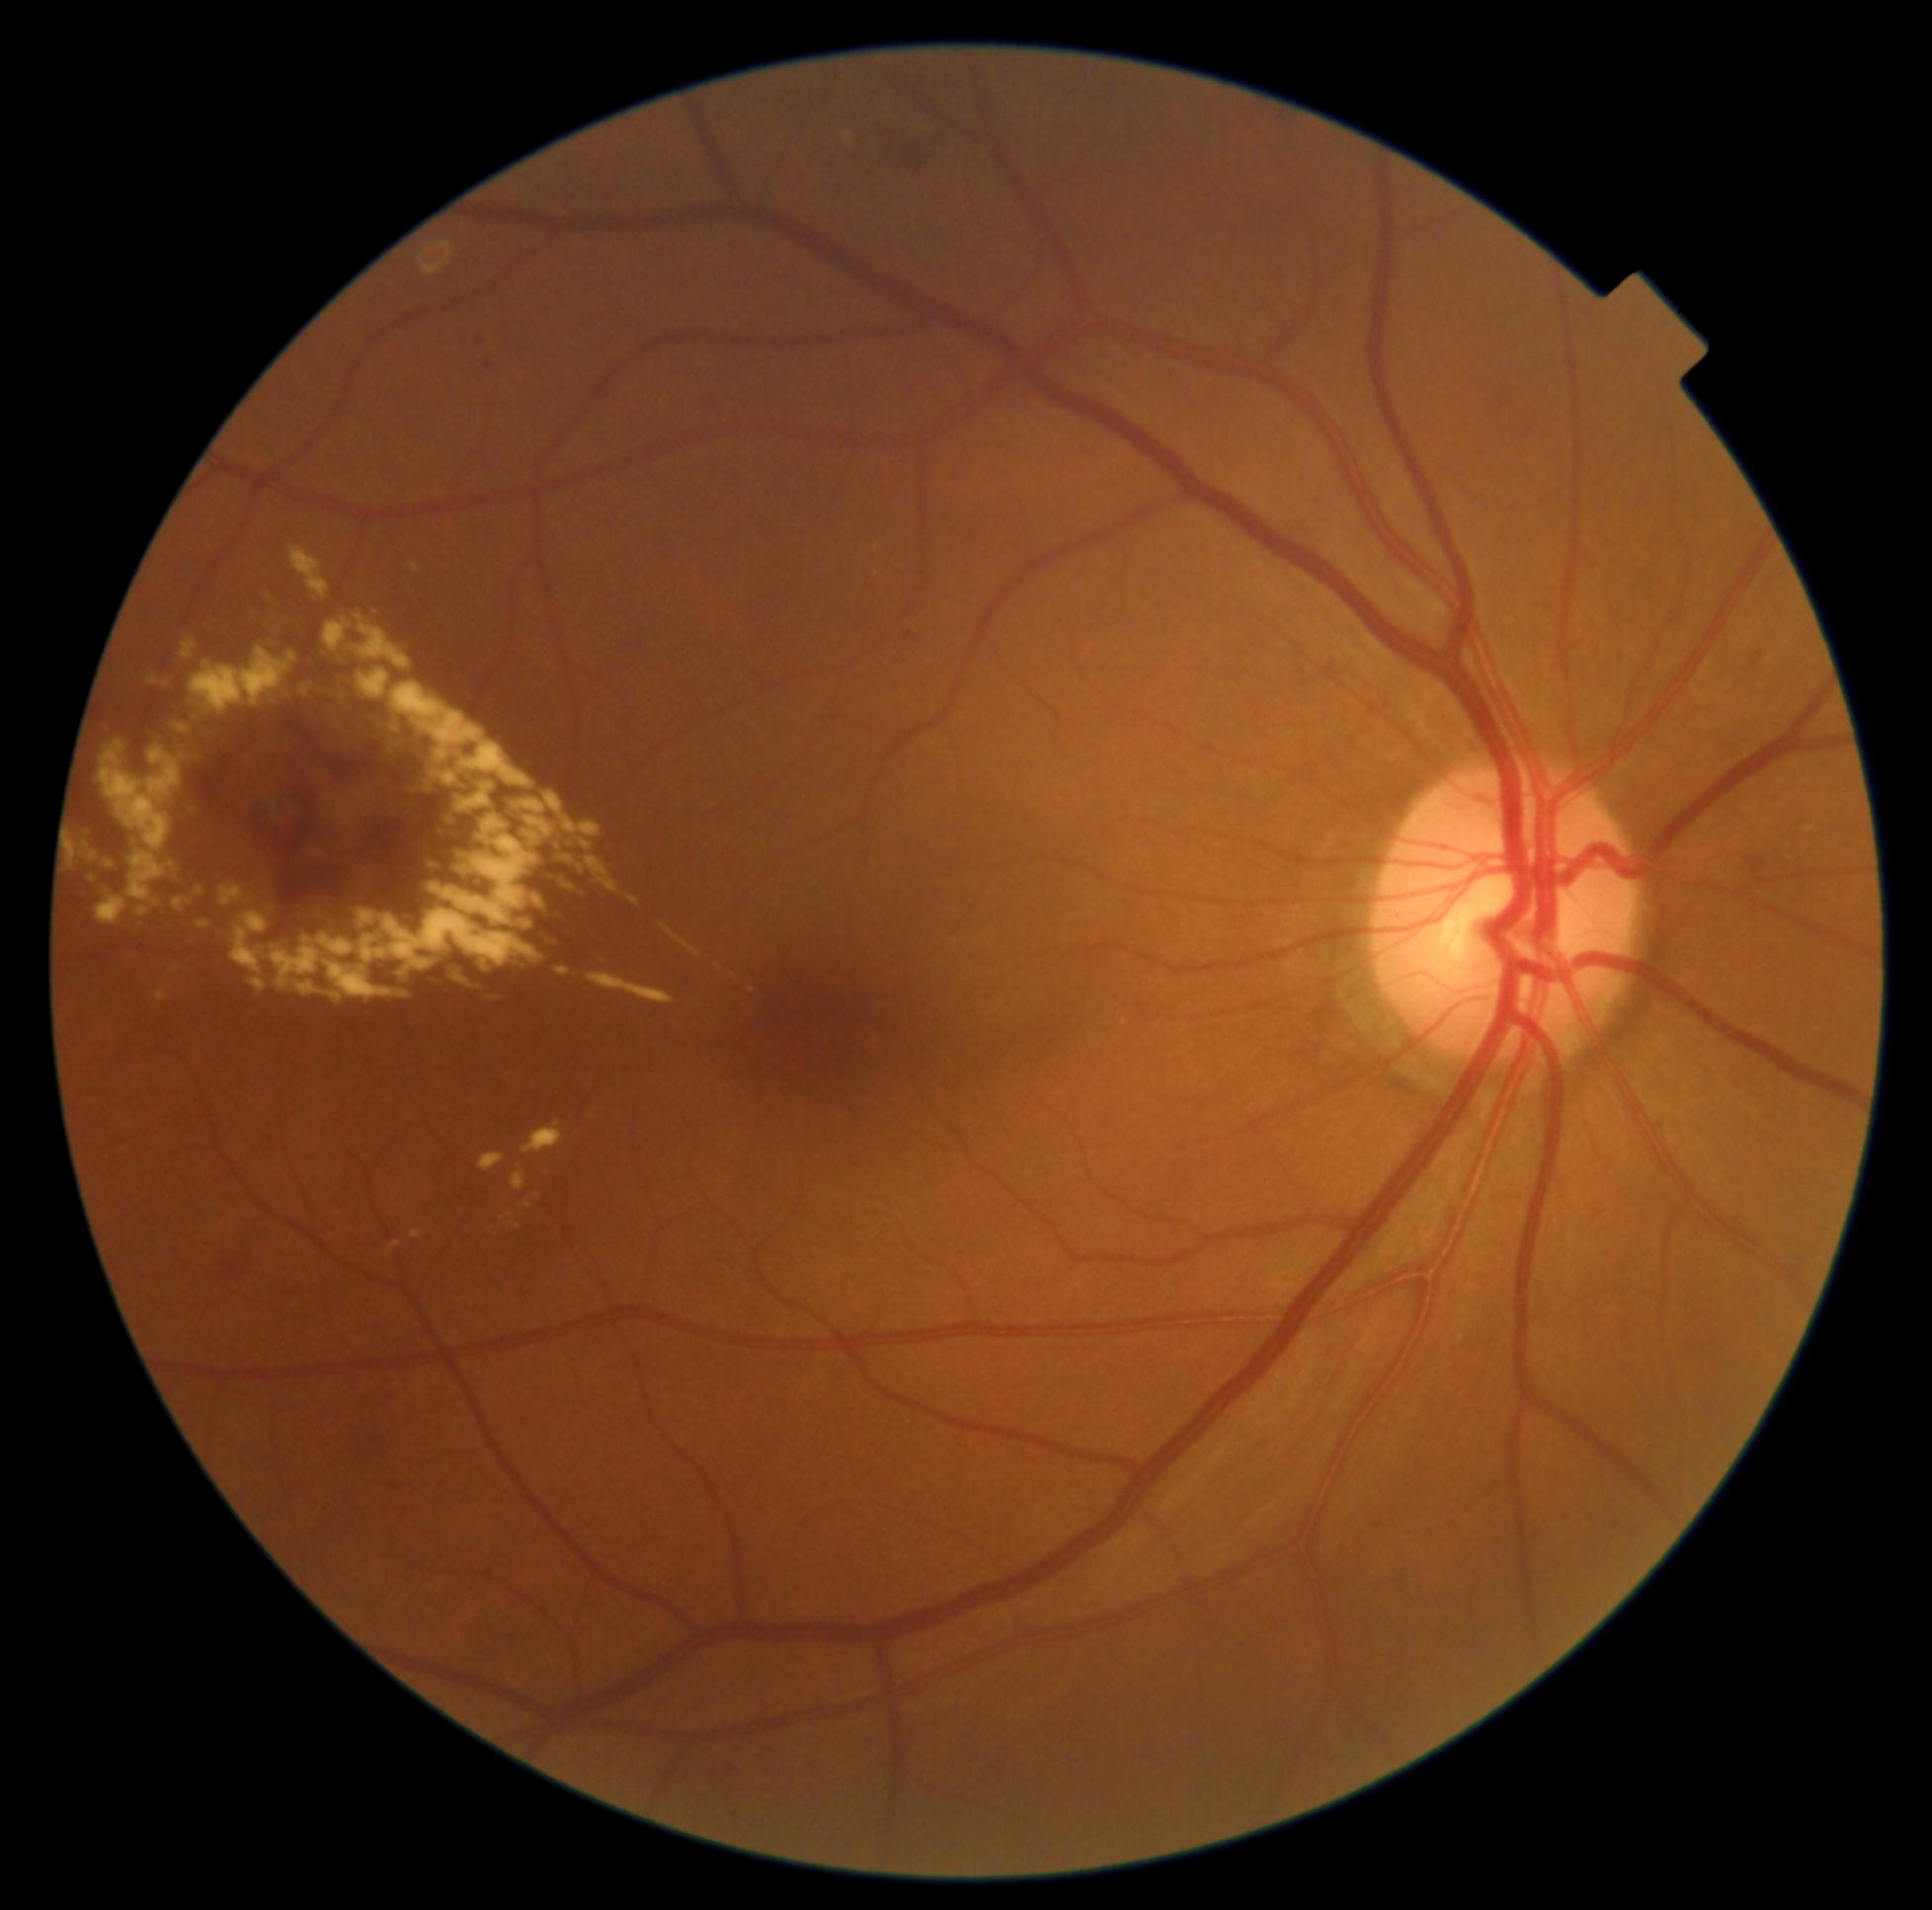
<lesions partial="true">
  <dr_grade>2</dr_grade>
  <ex partial="true">{"left": 480, "top": 1153, "right": 507, "bottom": 1170} | {"left": 181, "top": 639, "right": 197, "bottom": 661} | {"left": 250, "top": 979, "right": 267, "bottom": 992} | {"left": 443, "top": 965, "right": 478, "bottom": 994} | {"left": 443, "top": 816, "right": 454, "bottom": 829} | {"left": 186, "top": 798, "right": 193, "bottom": 813} | {"left": 390, "top": 1240, "right": 401, "bottom": 1251} | {"left": 153, "top": 992, "right": 168, "bottom": 1002} | {"left": 626, "top": 895, "right": 641, "bottom": 908} | {"left": 128, "top": 841, "right": 166, "bottom": 908} | {"left": 374, "top": 606, "right": 379, "bottom": 615} | {"left": 102, "top": 741, "right": 182, "bottom": 852} | {"left": 89, "top": 875, "right": 98, "bottom": 879} | {"left": 588, "top": 857, "right": 623, "bottom": 895} | {"left": 197, "top": 886, "right": 203, "bottom": 897}</ex>
  <ex_small_approx>(x=582, y=869)</ex_small_approx>
</lesions>